Camera: Clarity RetCam 3 (130° FOV). Wide-field fundus image from infant ROP screening — 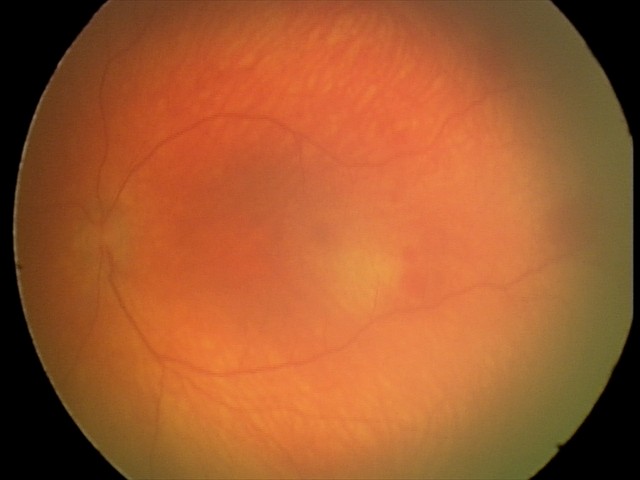 Screening examination with no abnormal retinal findings.